Infant wide-field fundus photograph — 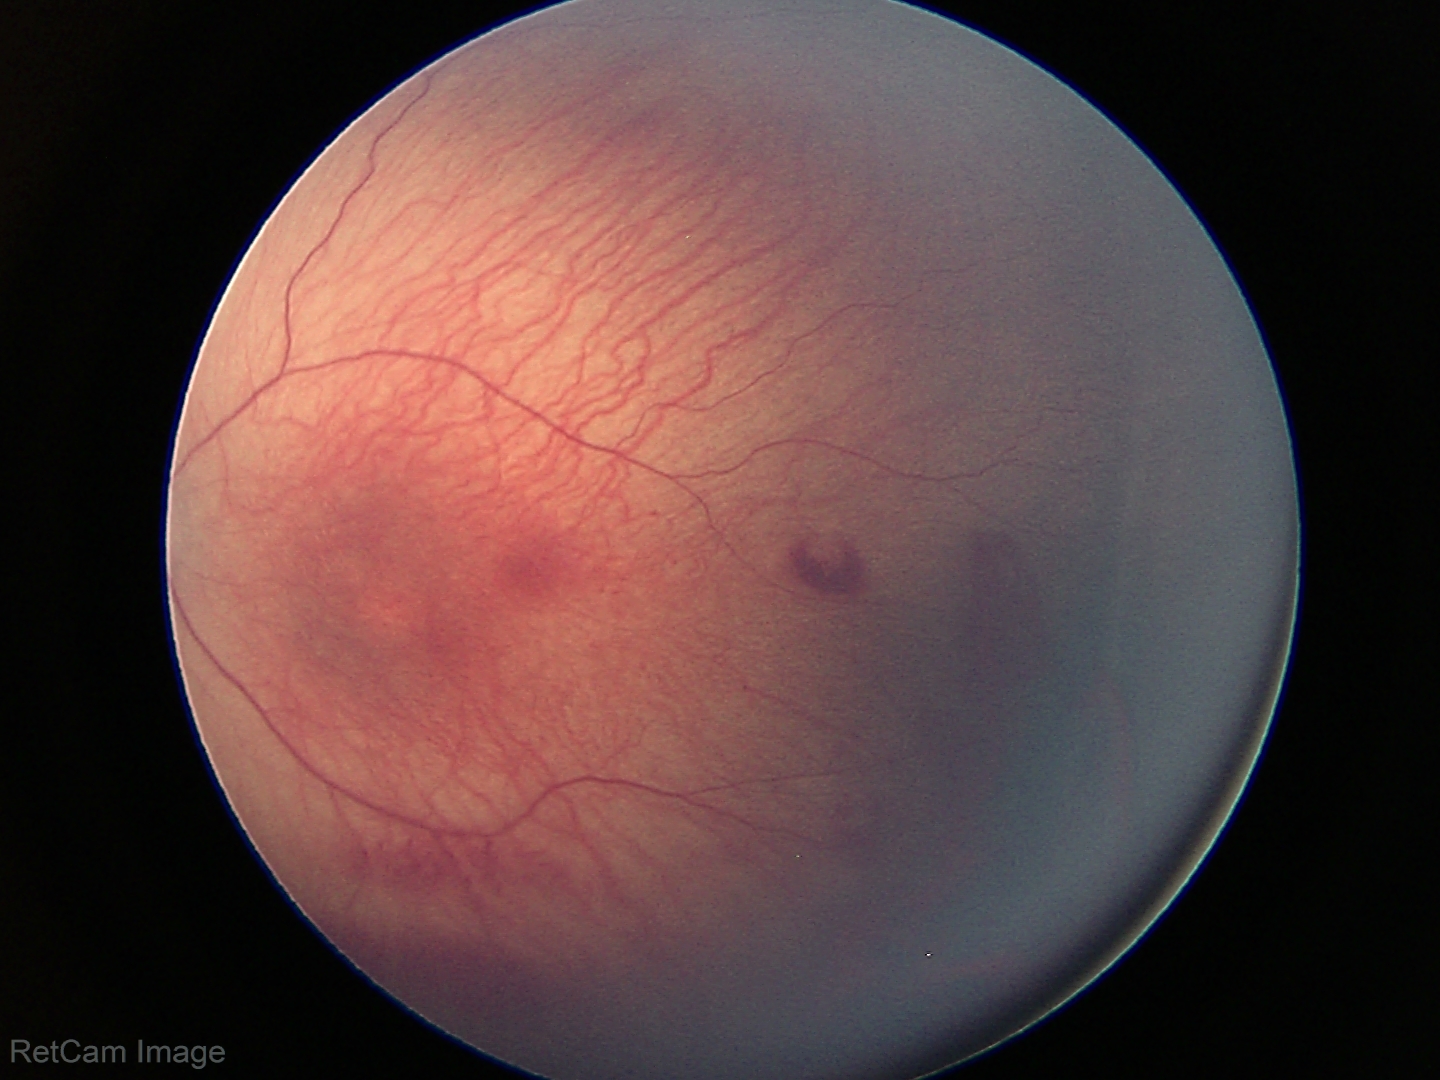

Plus disease absent. Series diagnosed as ROP stage 1.